UWF retinal mosaic: 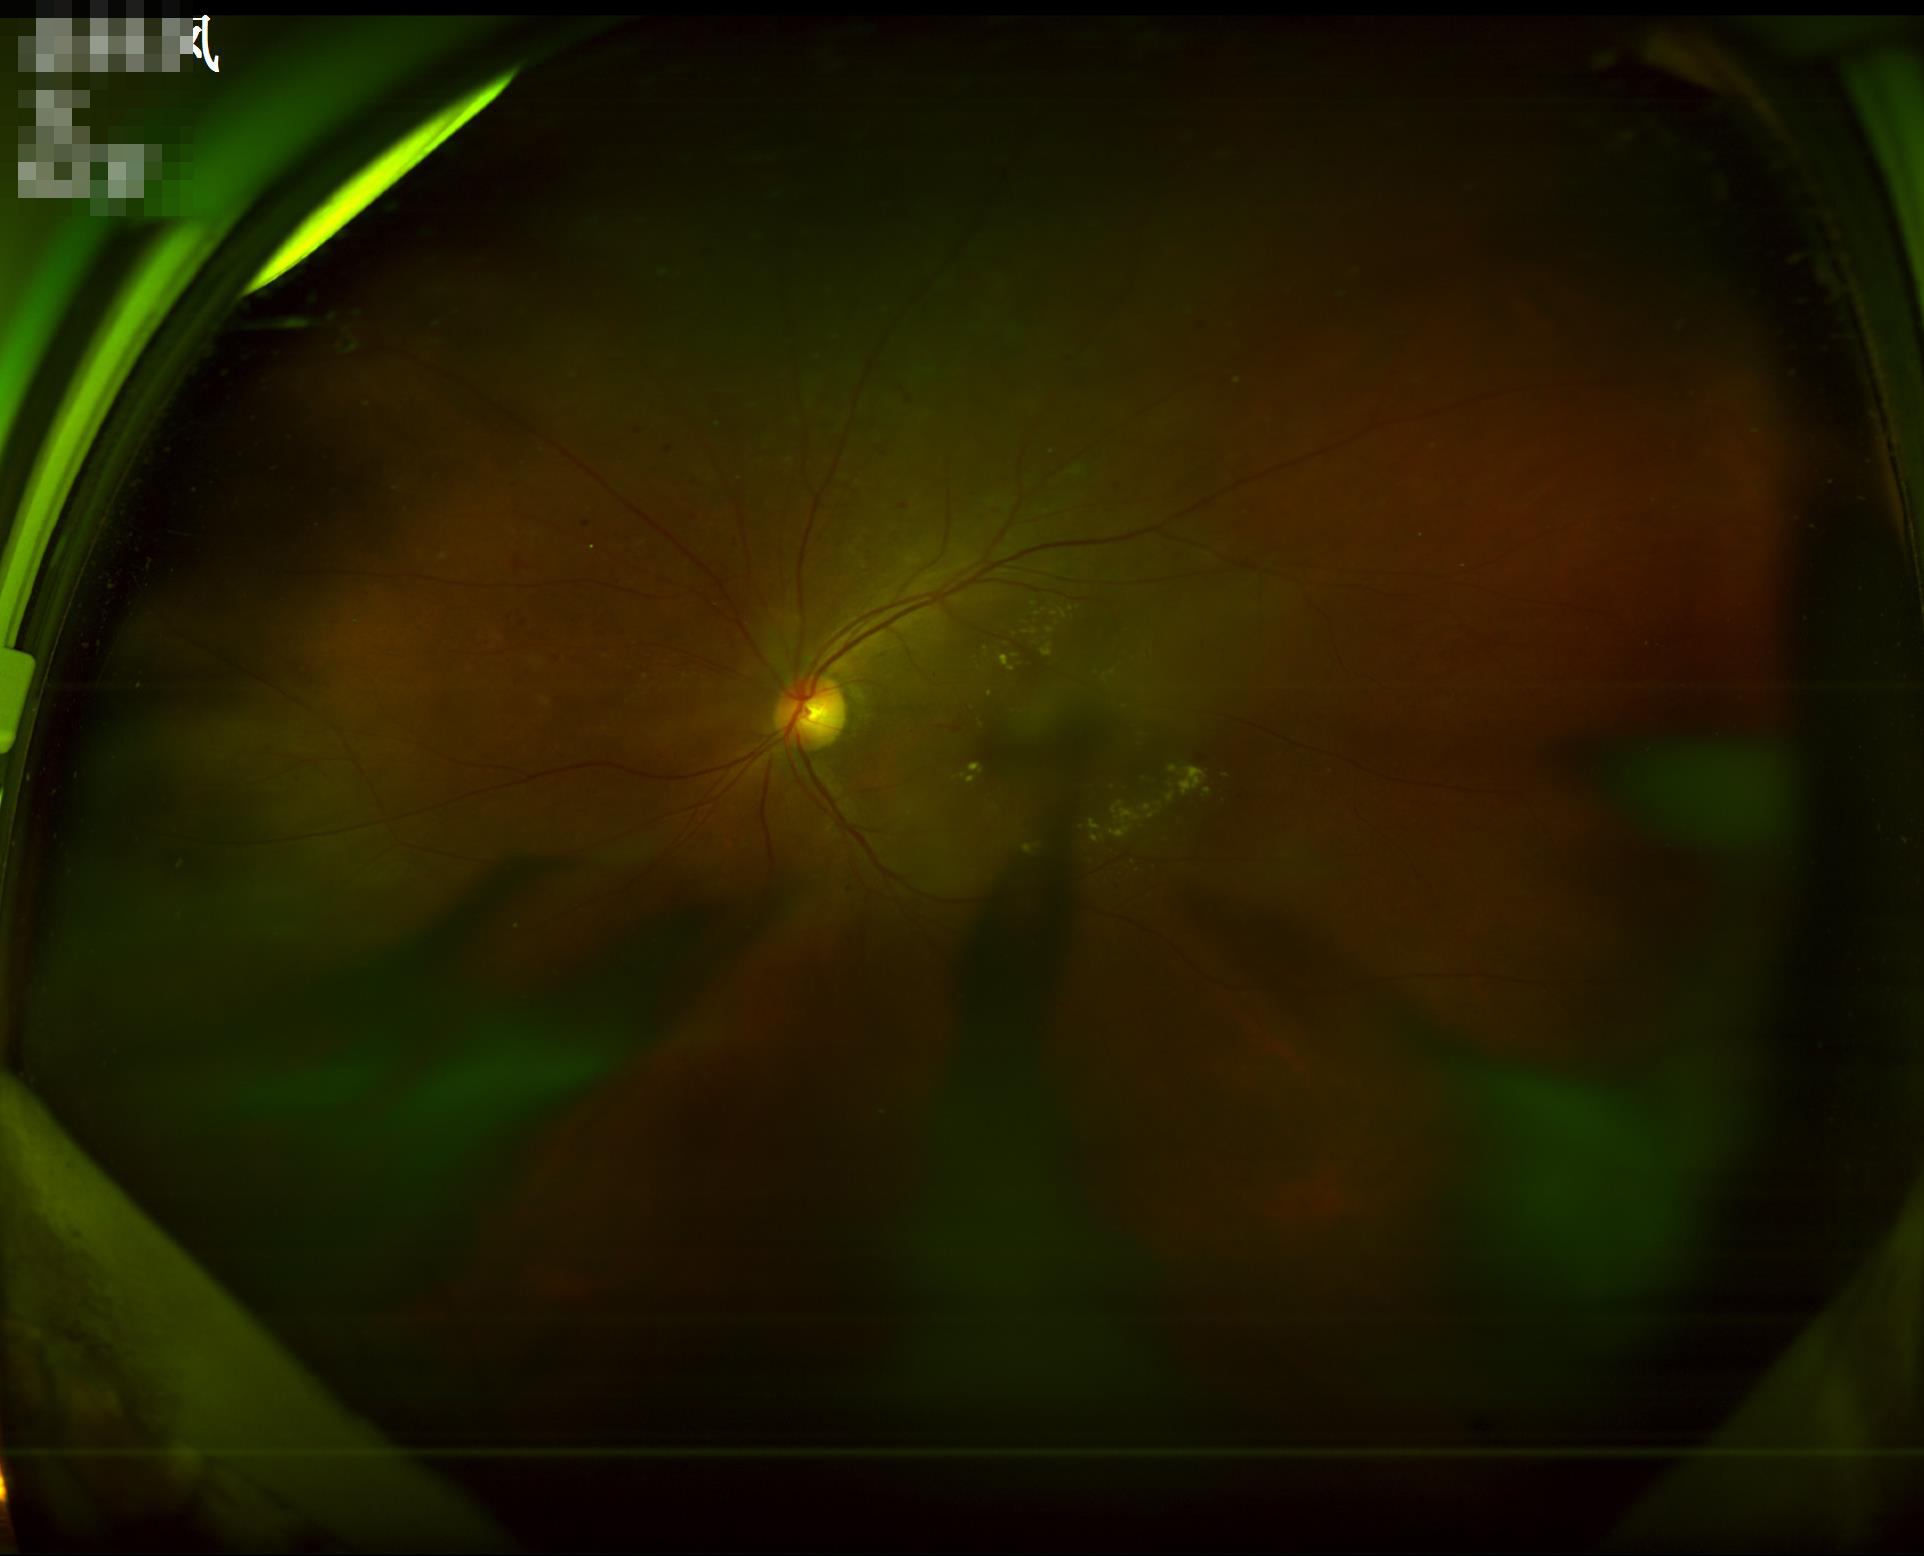
Clarity: poor
Overall: low
Illumination: suboptimal
Contrast: satisfactory